Infant wide-field retinal image. 1240 by 1240 pixels.
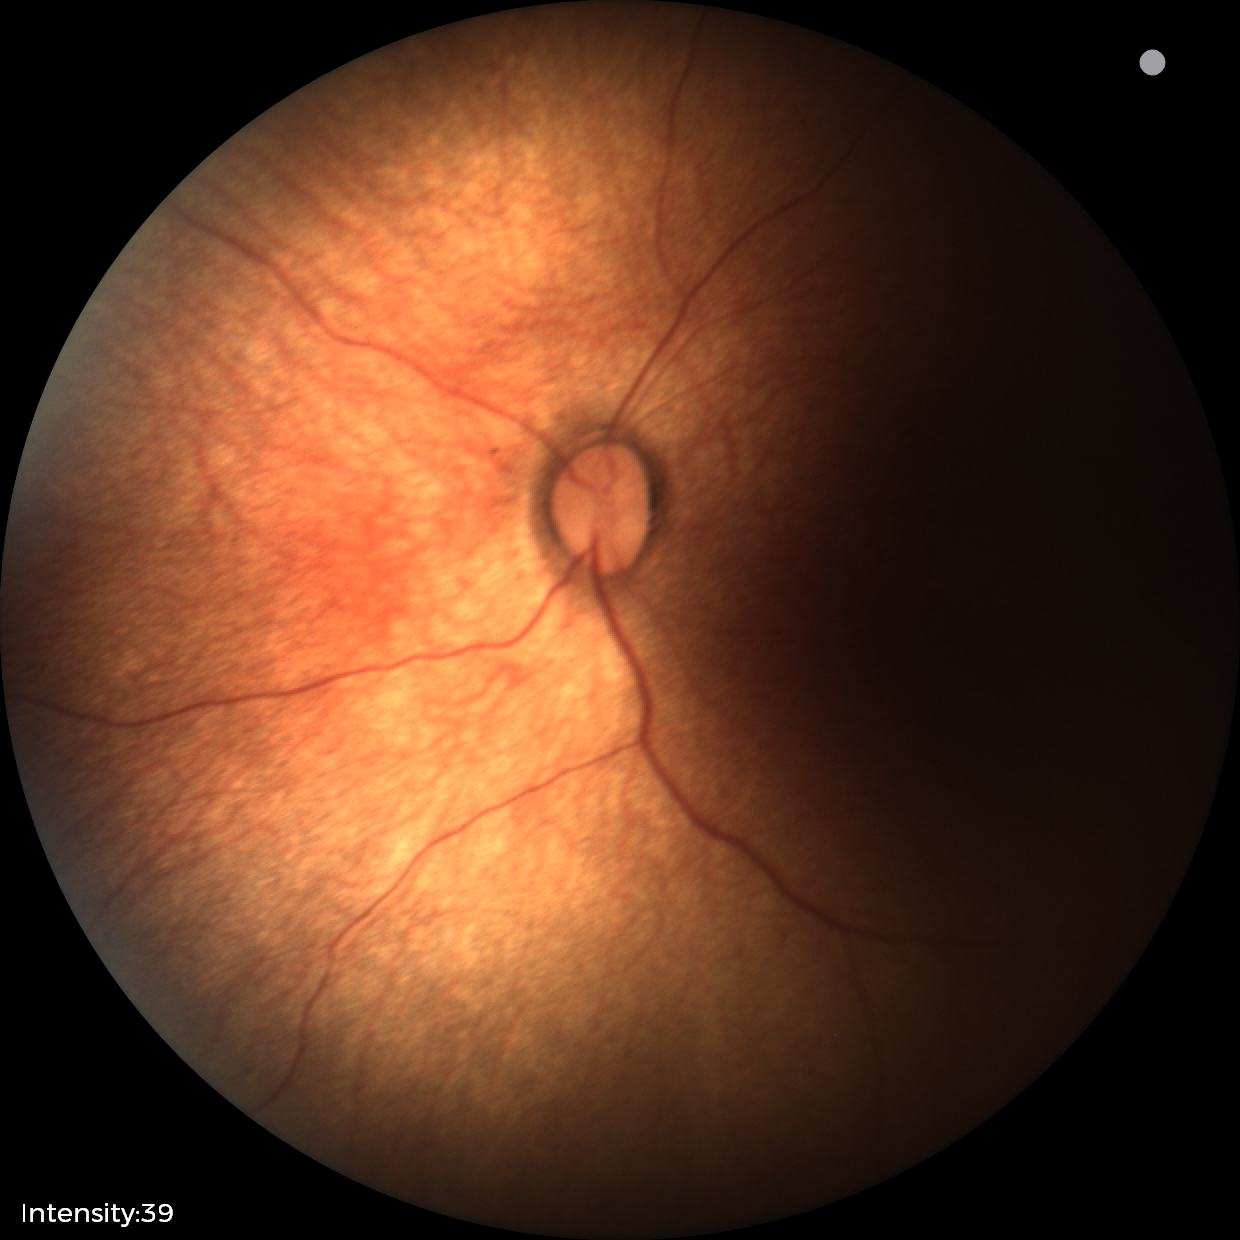

Finding = normal retinal appearance.